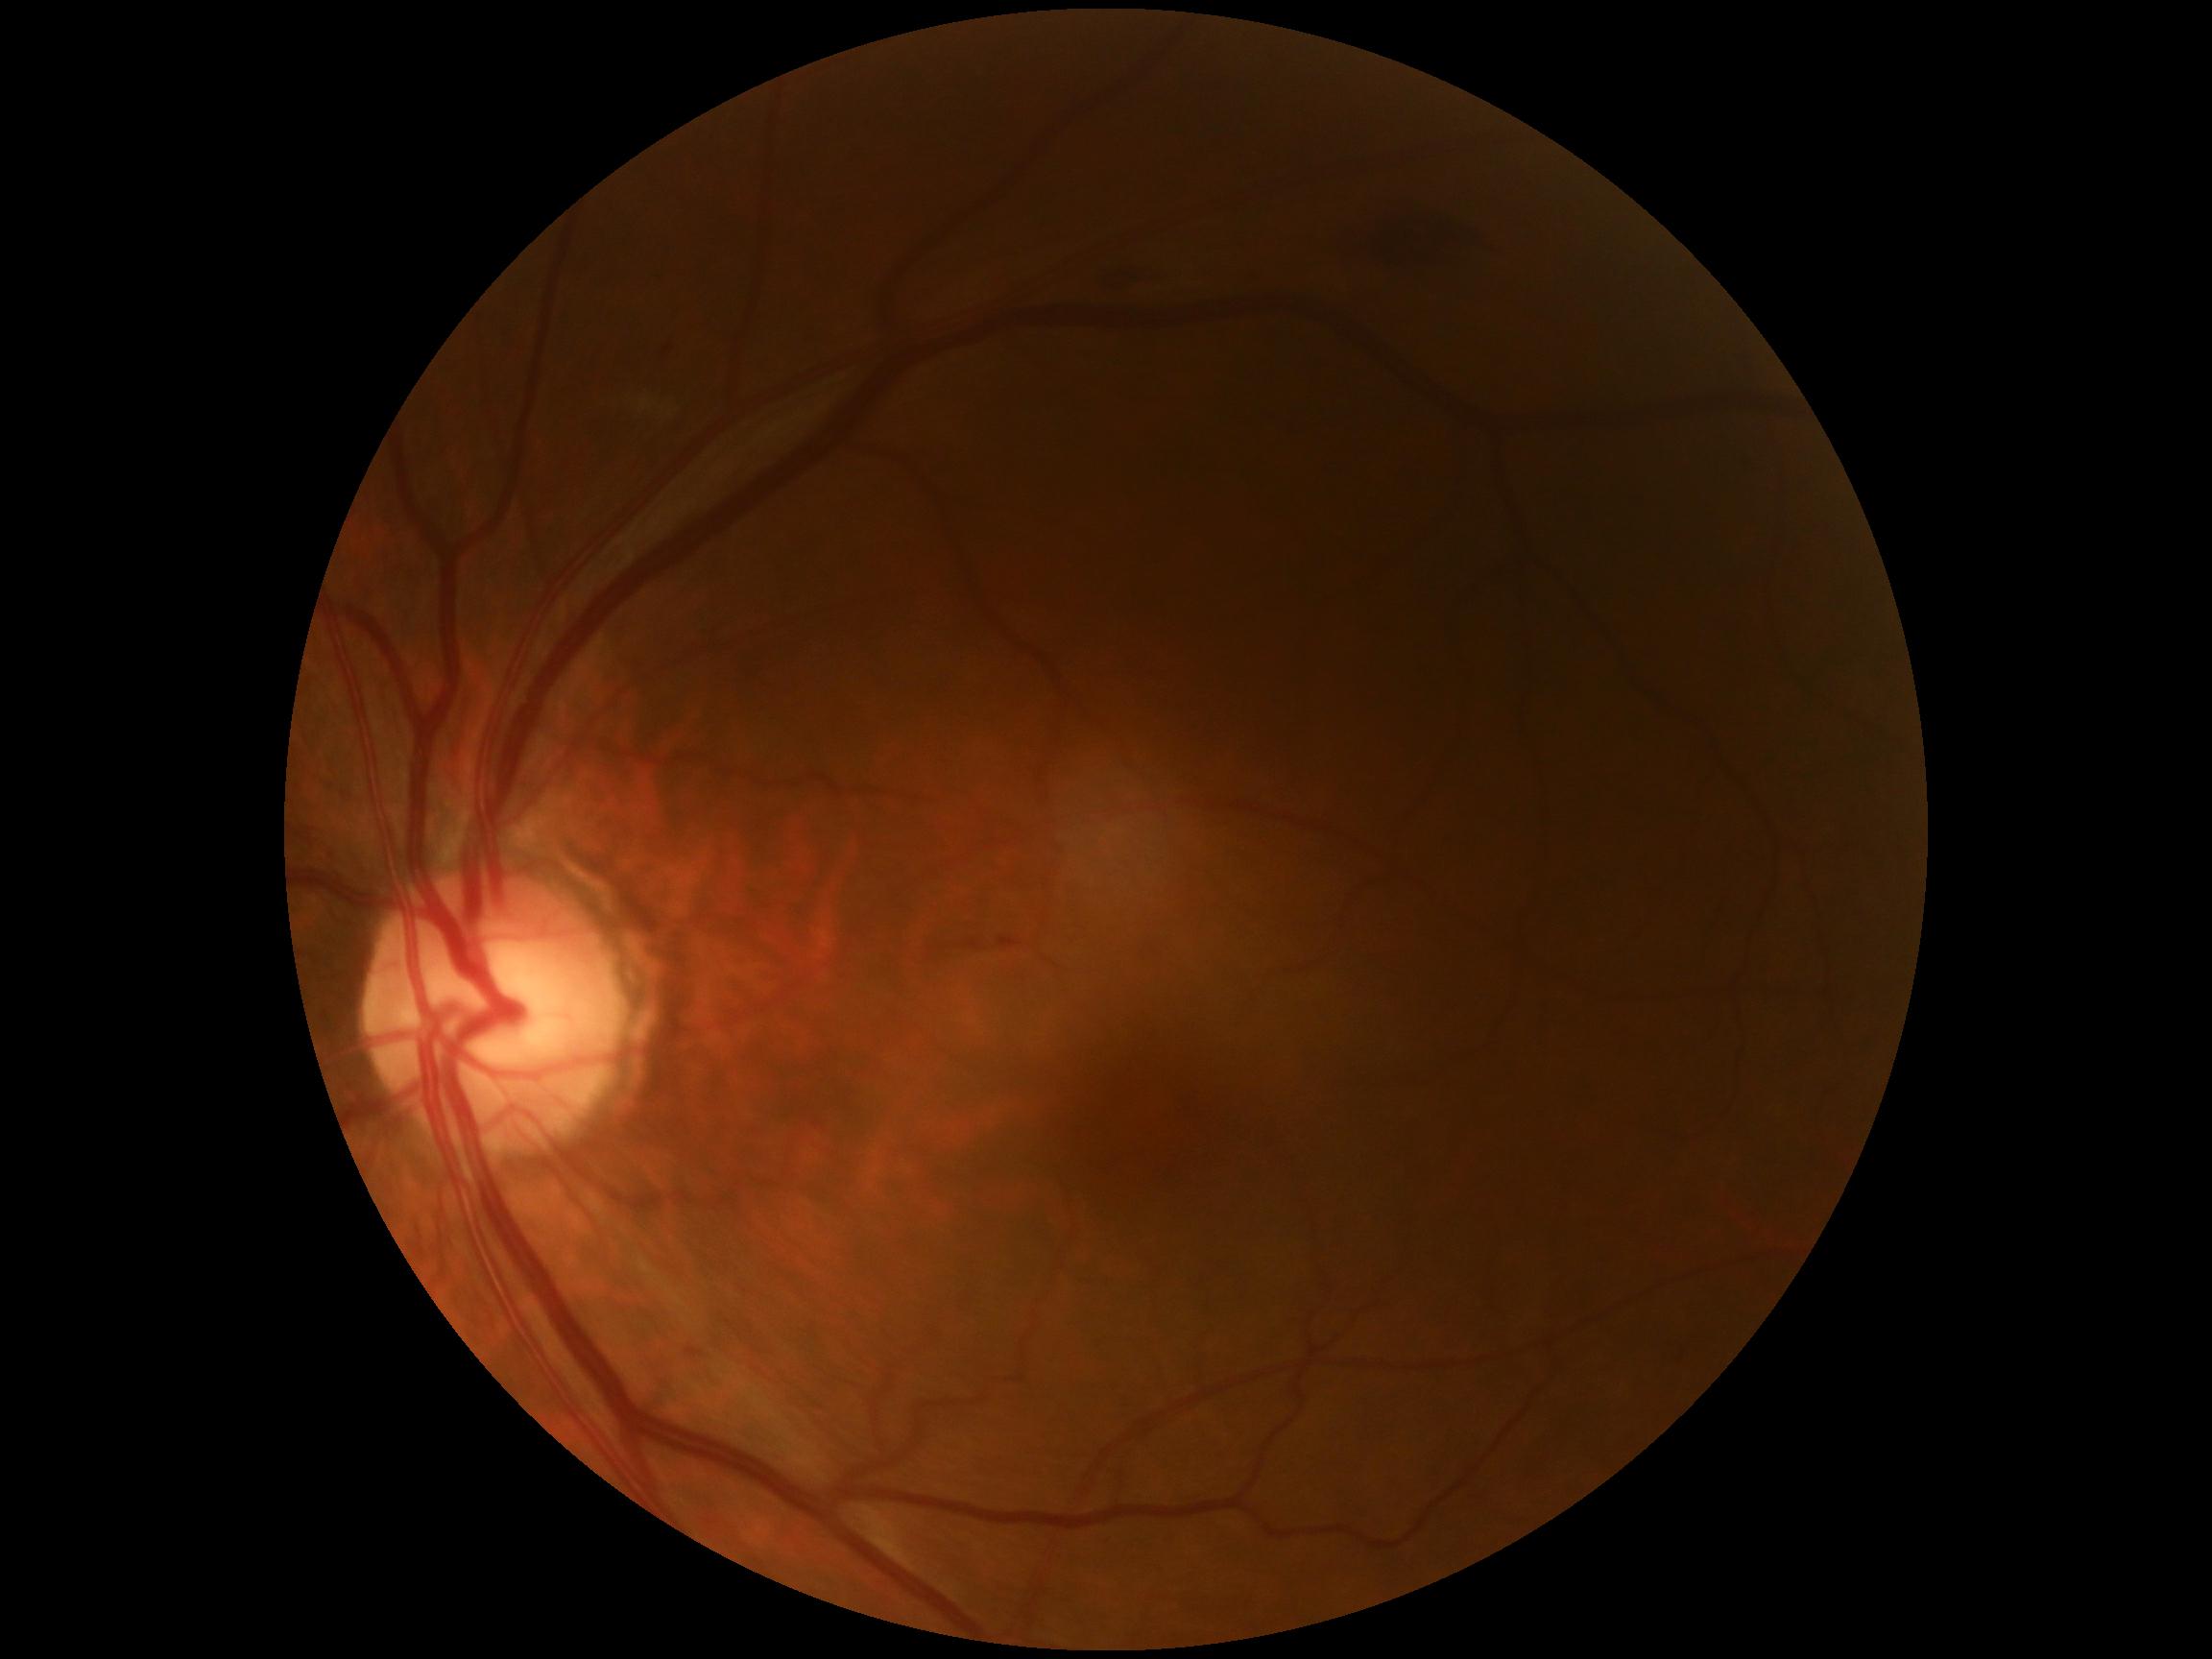 diabetic retinopathy (DR)@grade 2 (moderate NPDR), DR class@non-proliferative diabetic retinopathy.